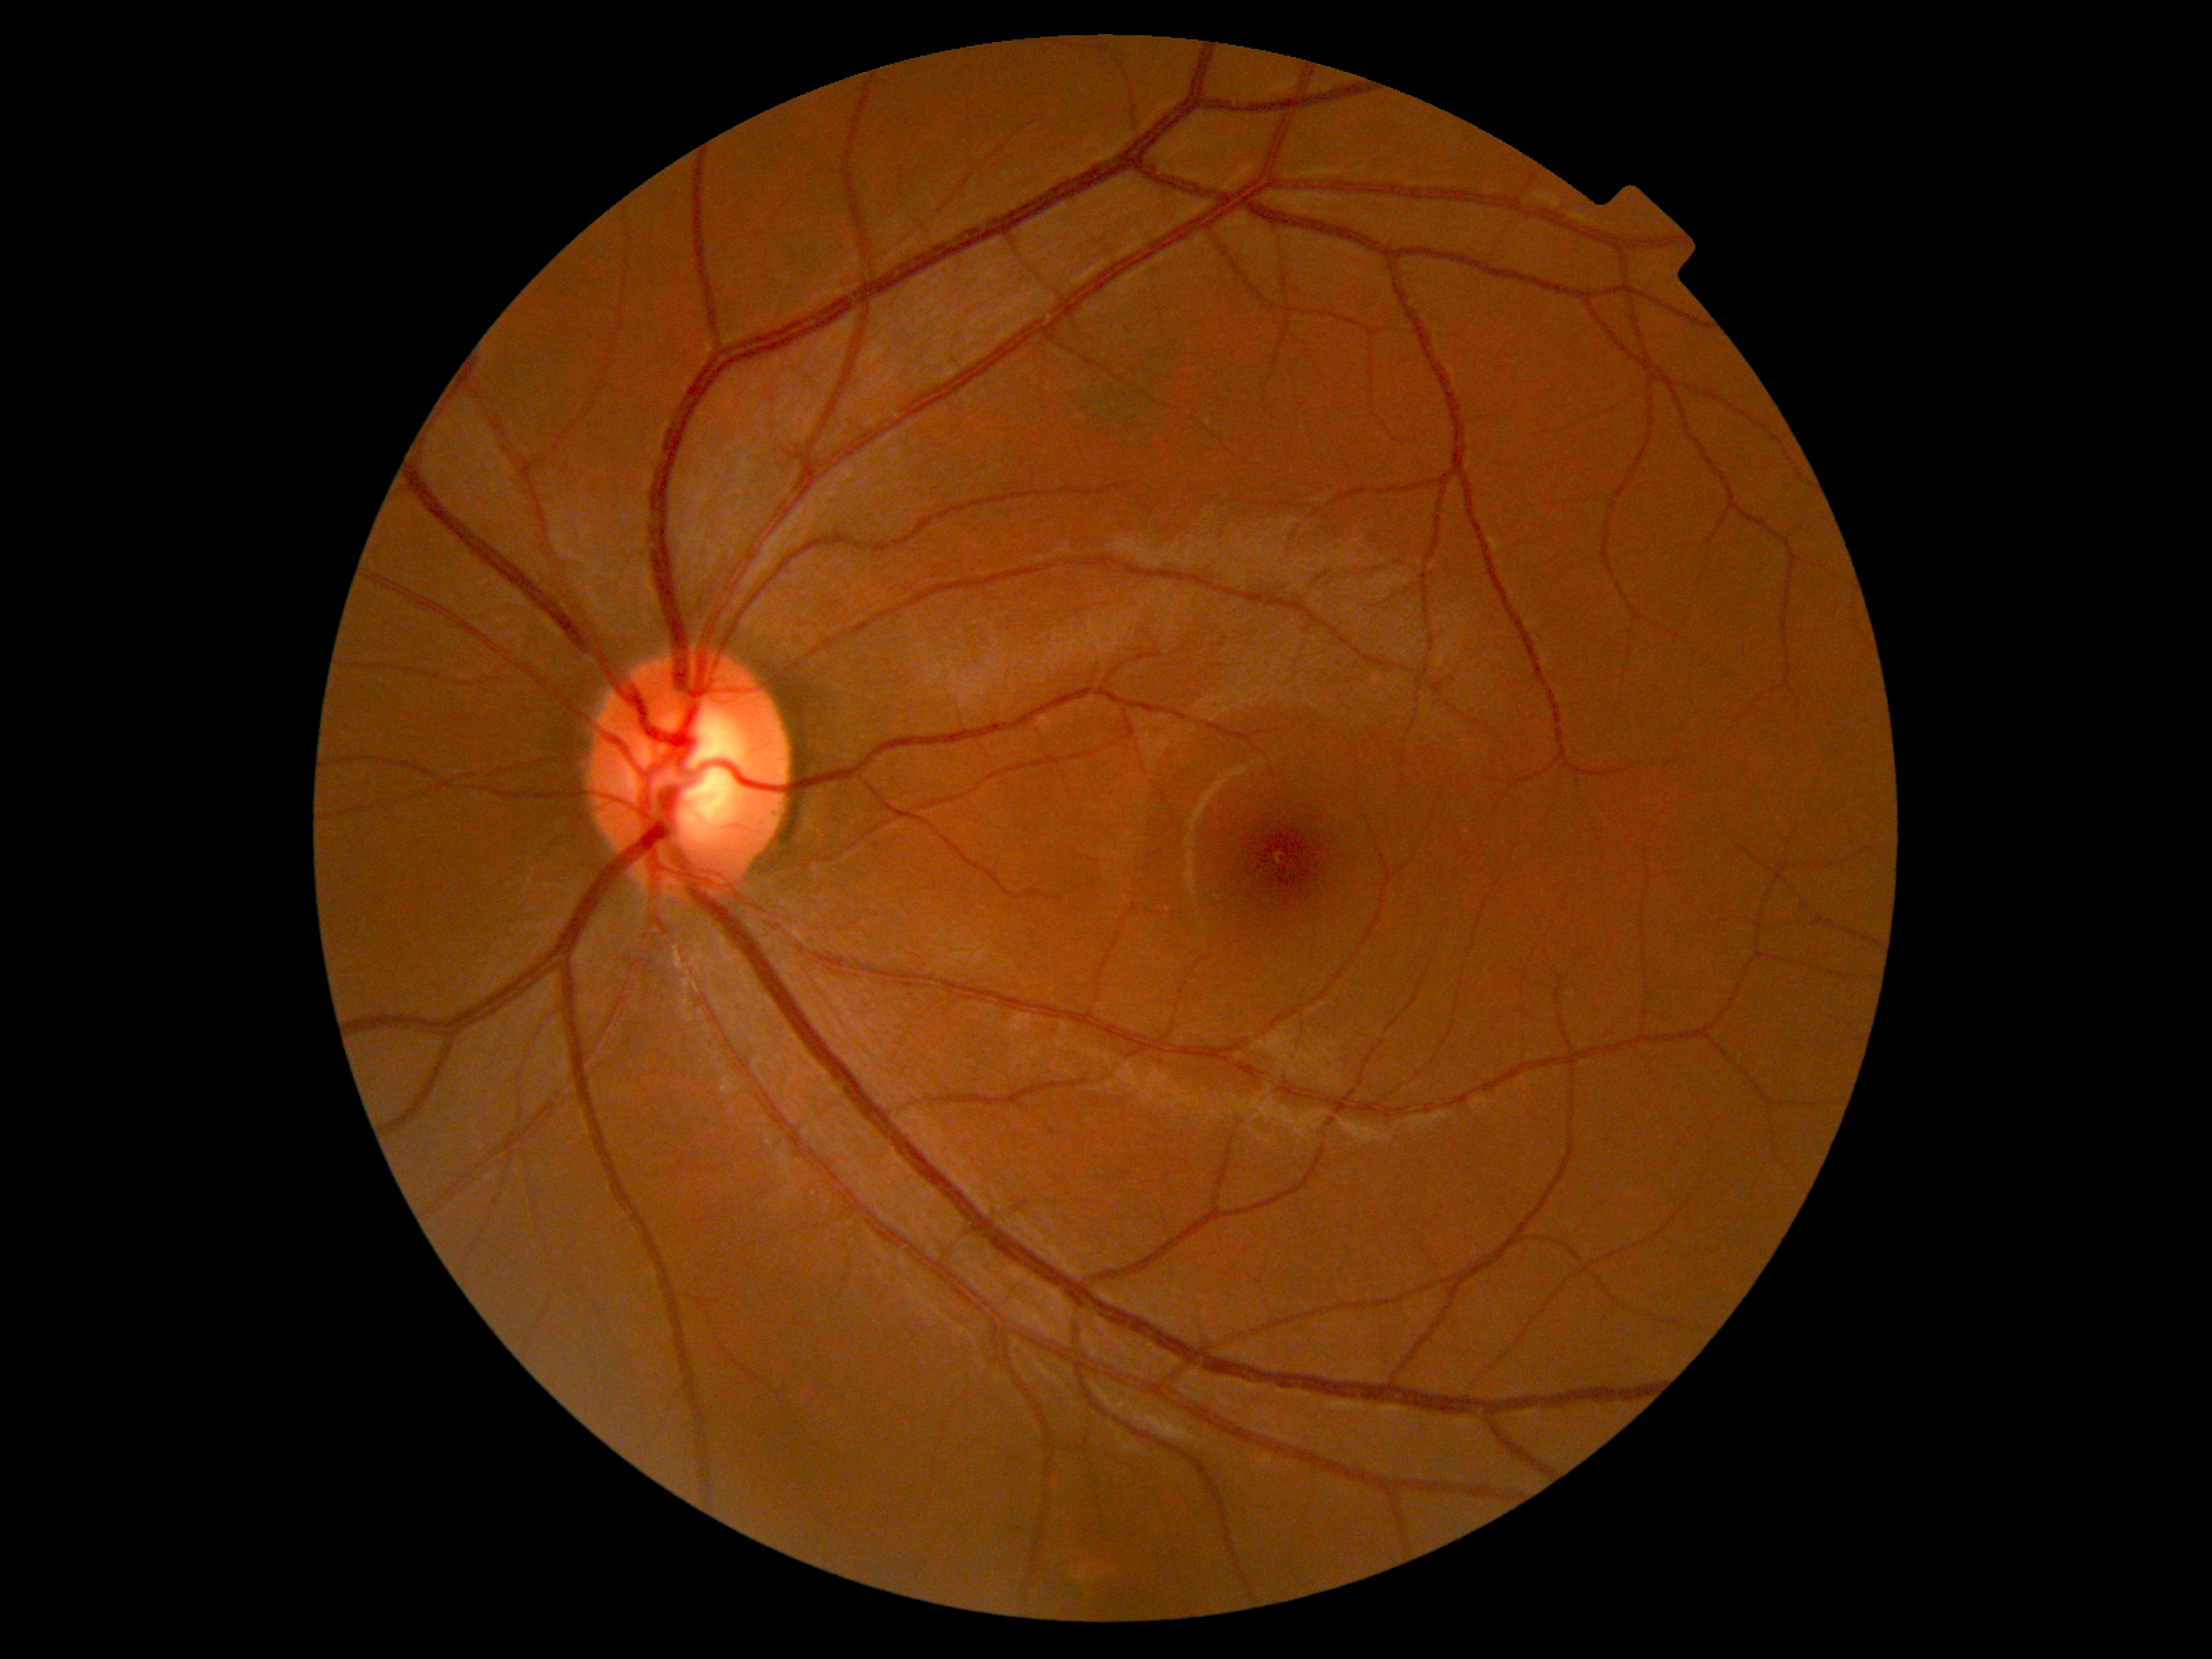 {"dr_grade": "0/4"}